45° FOV.
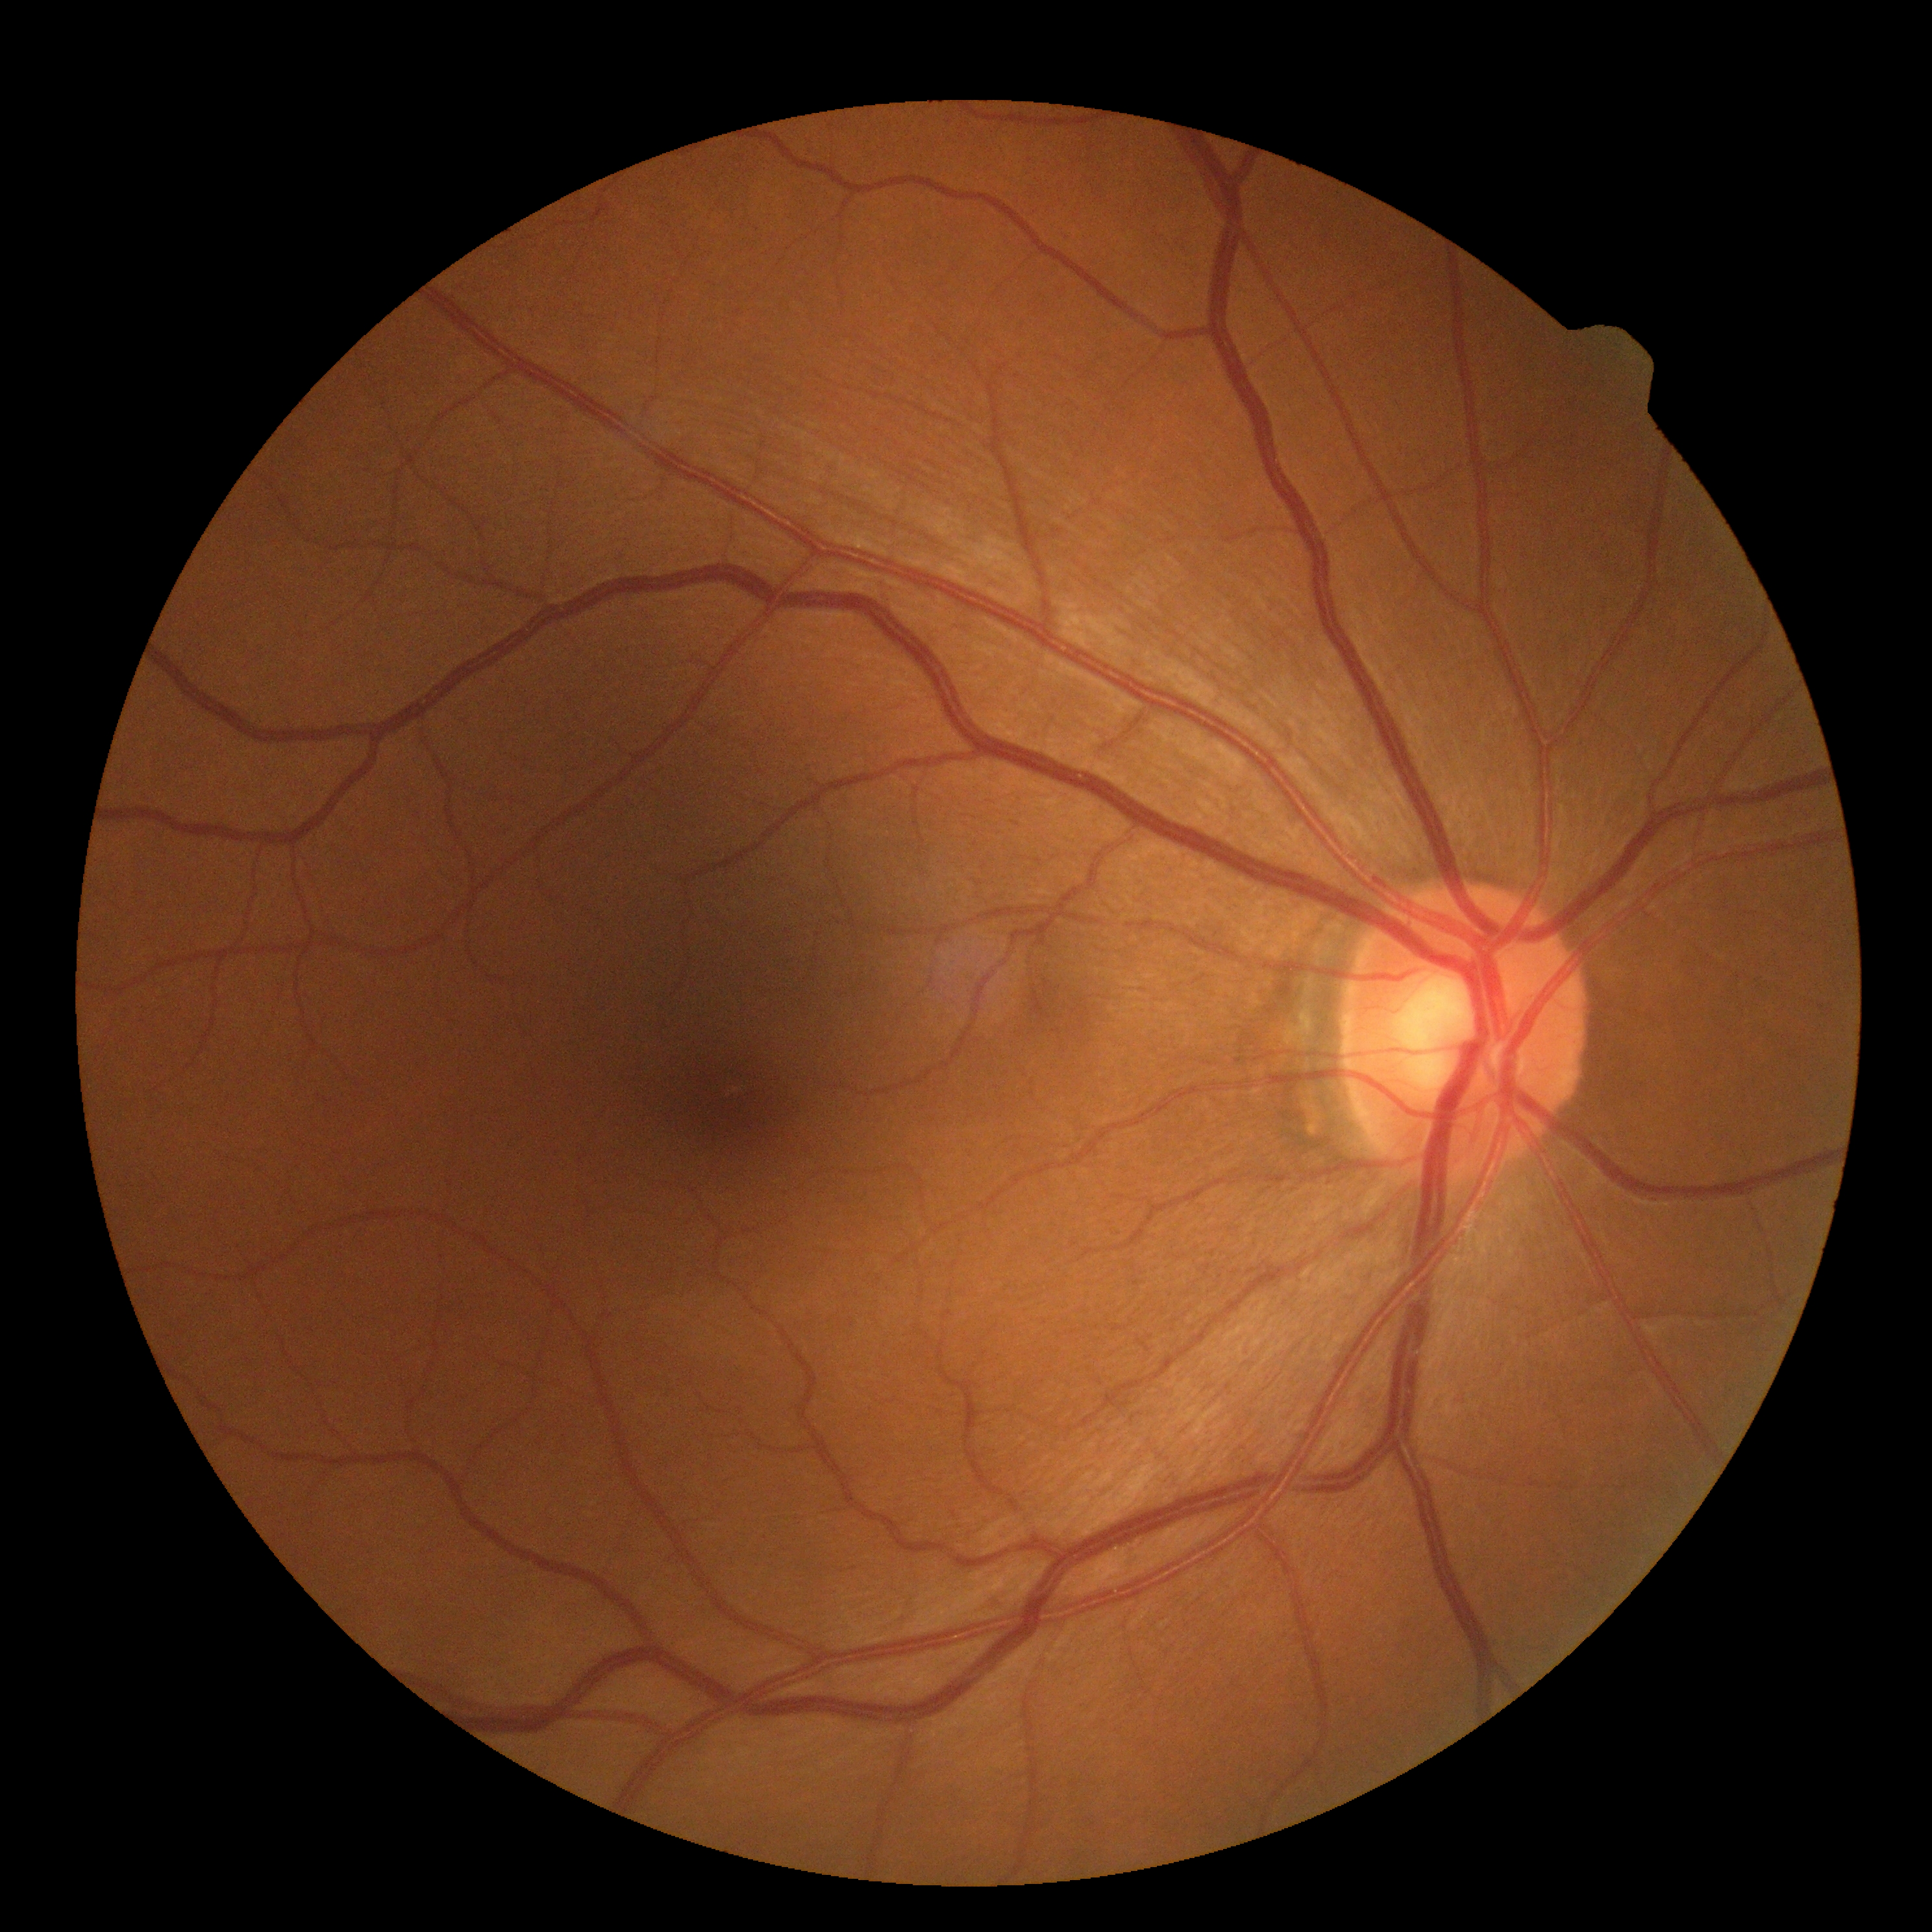

DR: grade 0 (no apparent retinopathy), DR impression: negative for DR.